Without pupil dilation, image size 848x848.
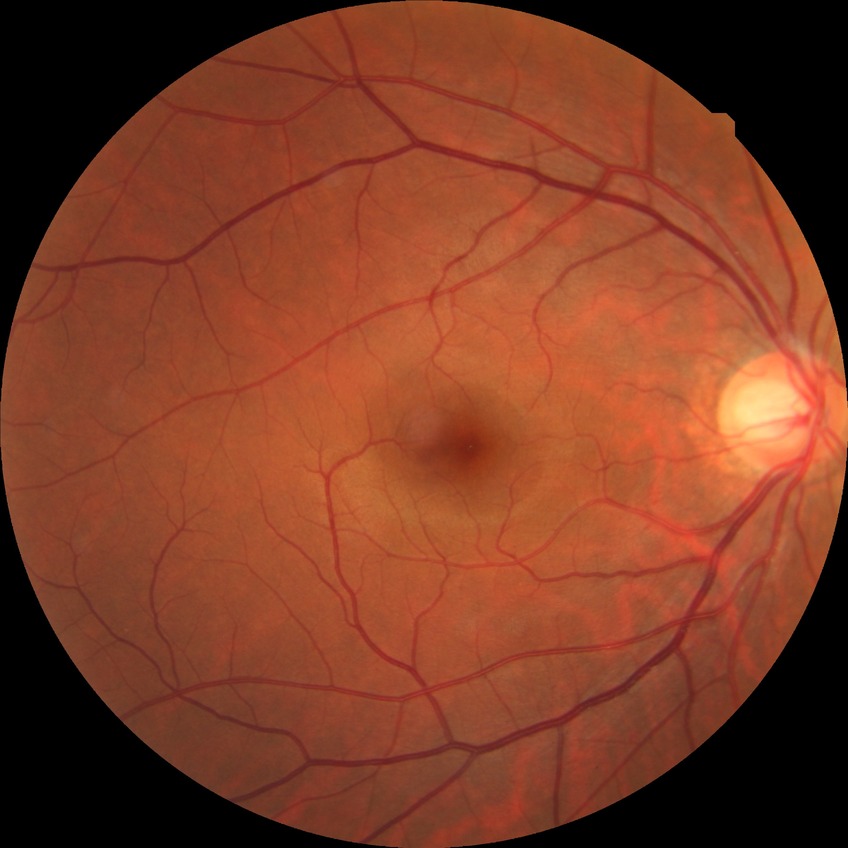

DR impression = no apparent DR, DR grade = NDR.